Wide-field fundus image from infant ROP screening.
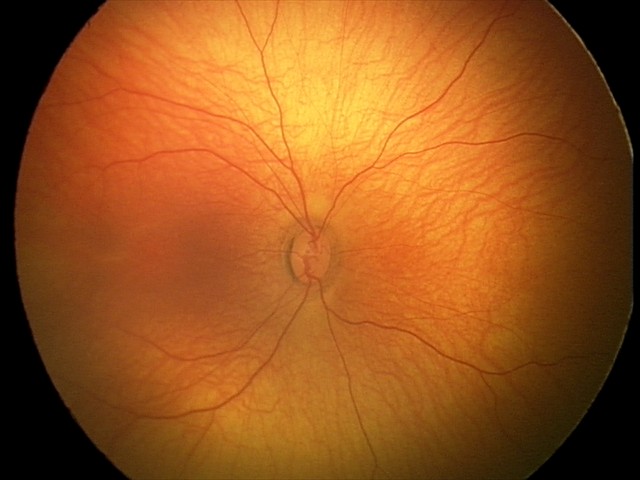

Screening diagnosis: no pathology identified